45° FOV — 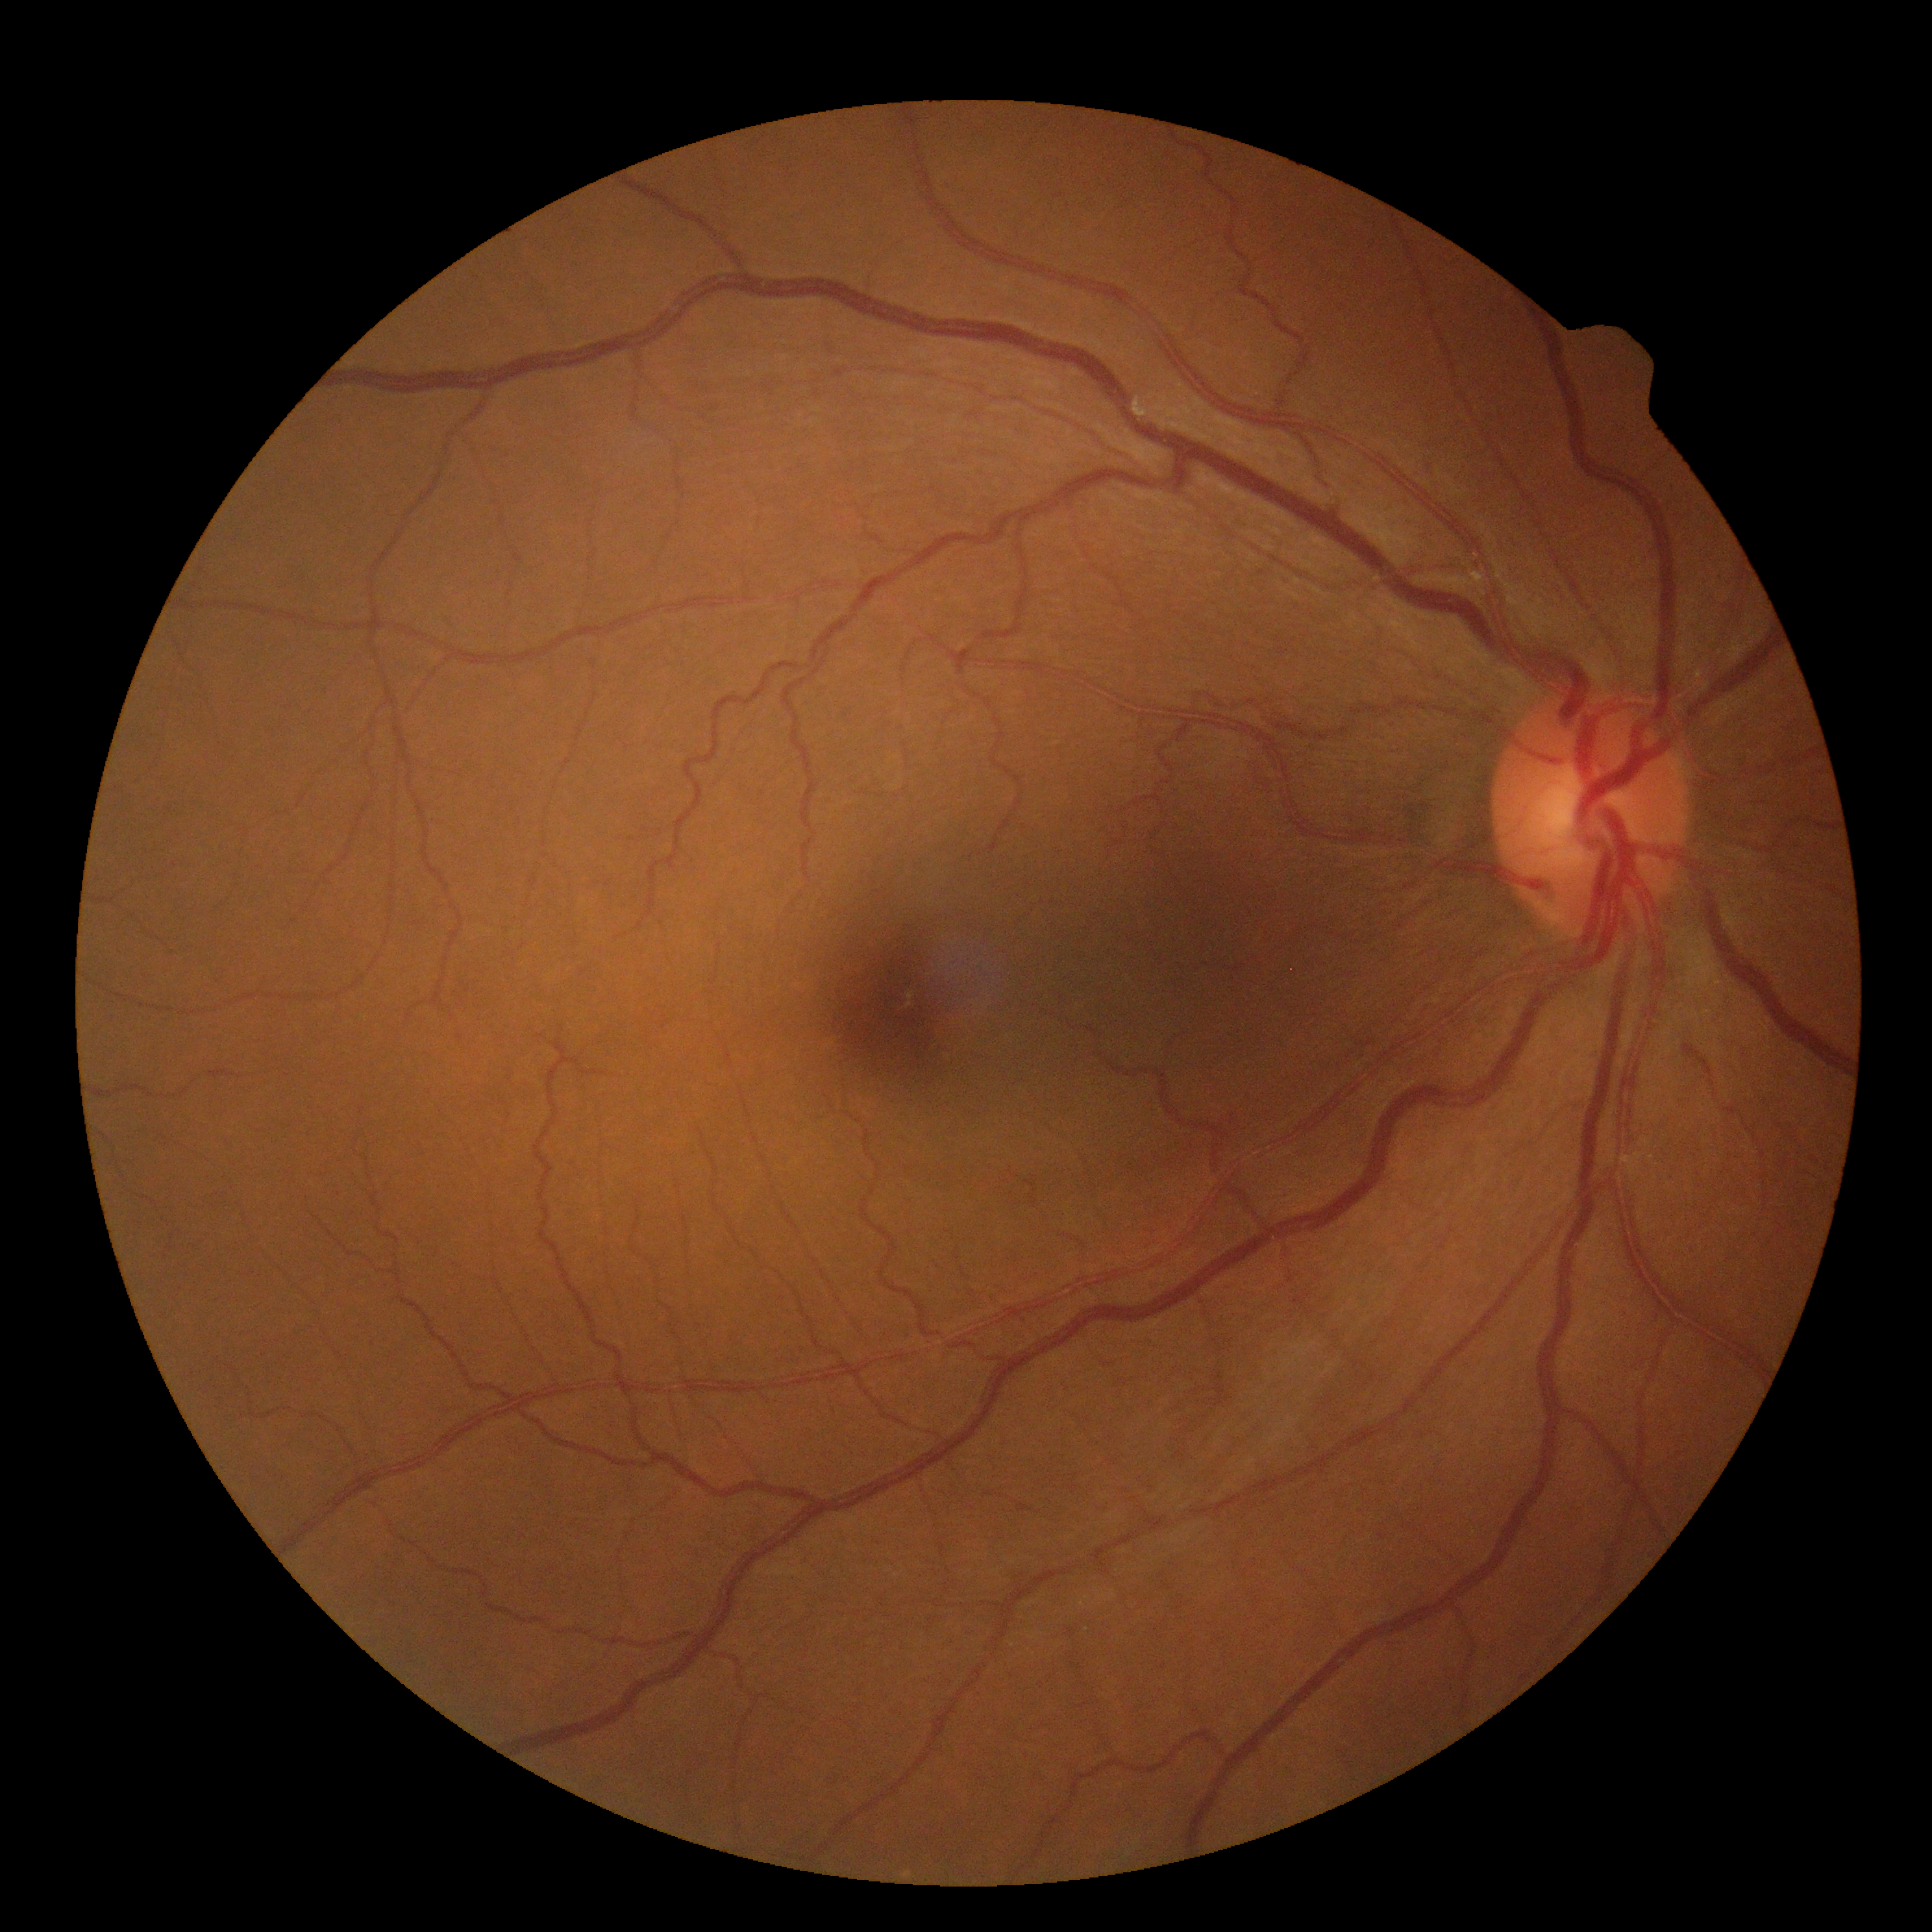
DR severity: grade 0 (no apparent retinopathy).
No diabetic retinal disease findings.